45° FOV
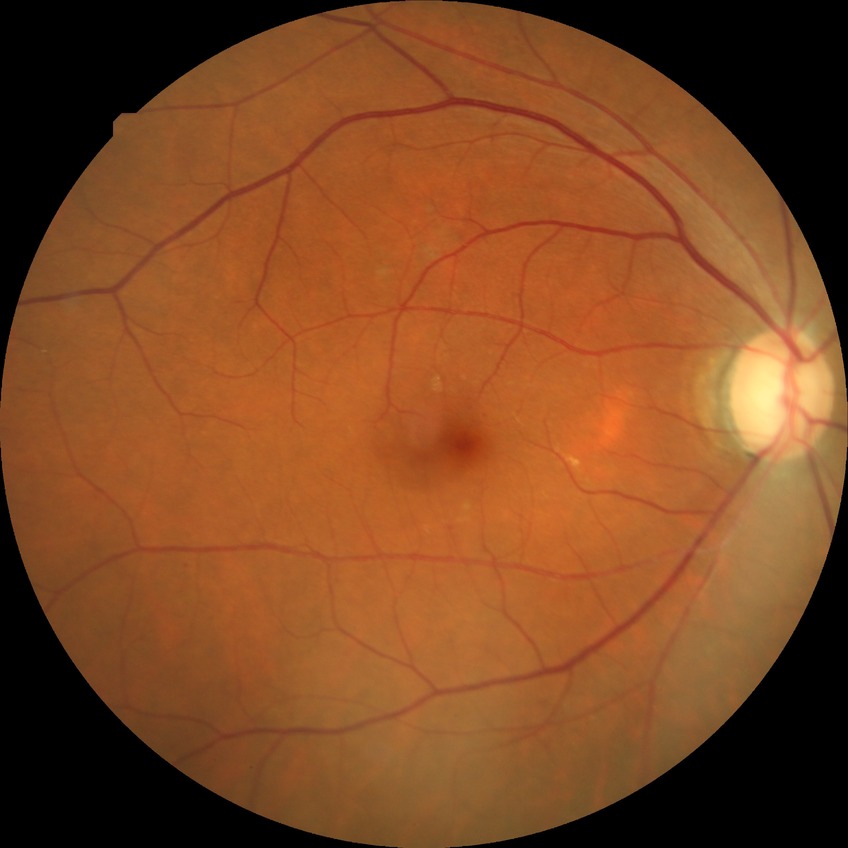 Diabetic retinopathy stage: simple diabetic retinopathy.